Image size 2212x1659 · retinal fundus photograph · FOV: 45 degrees: 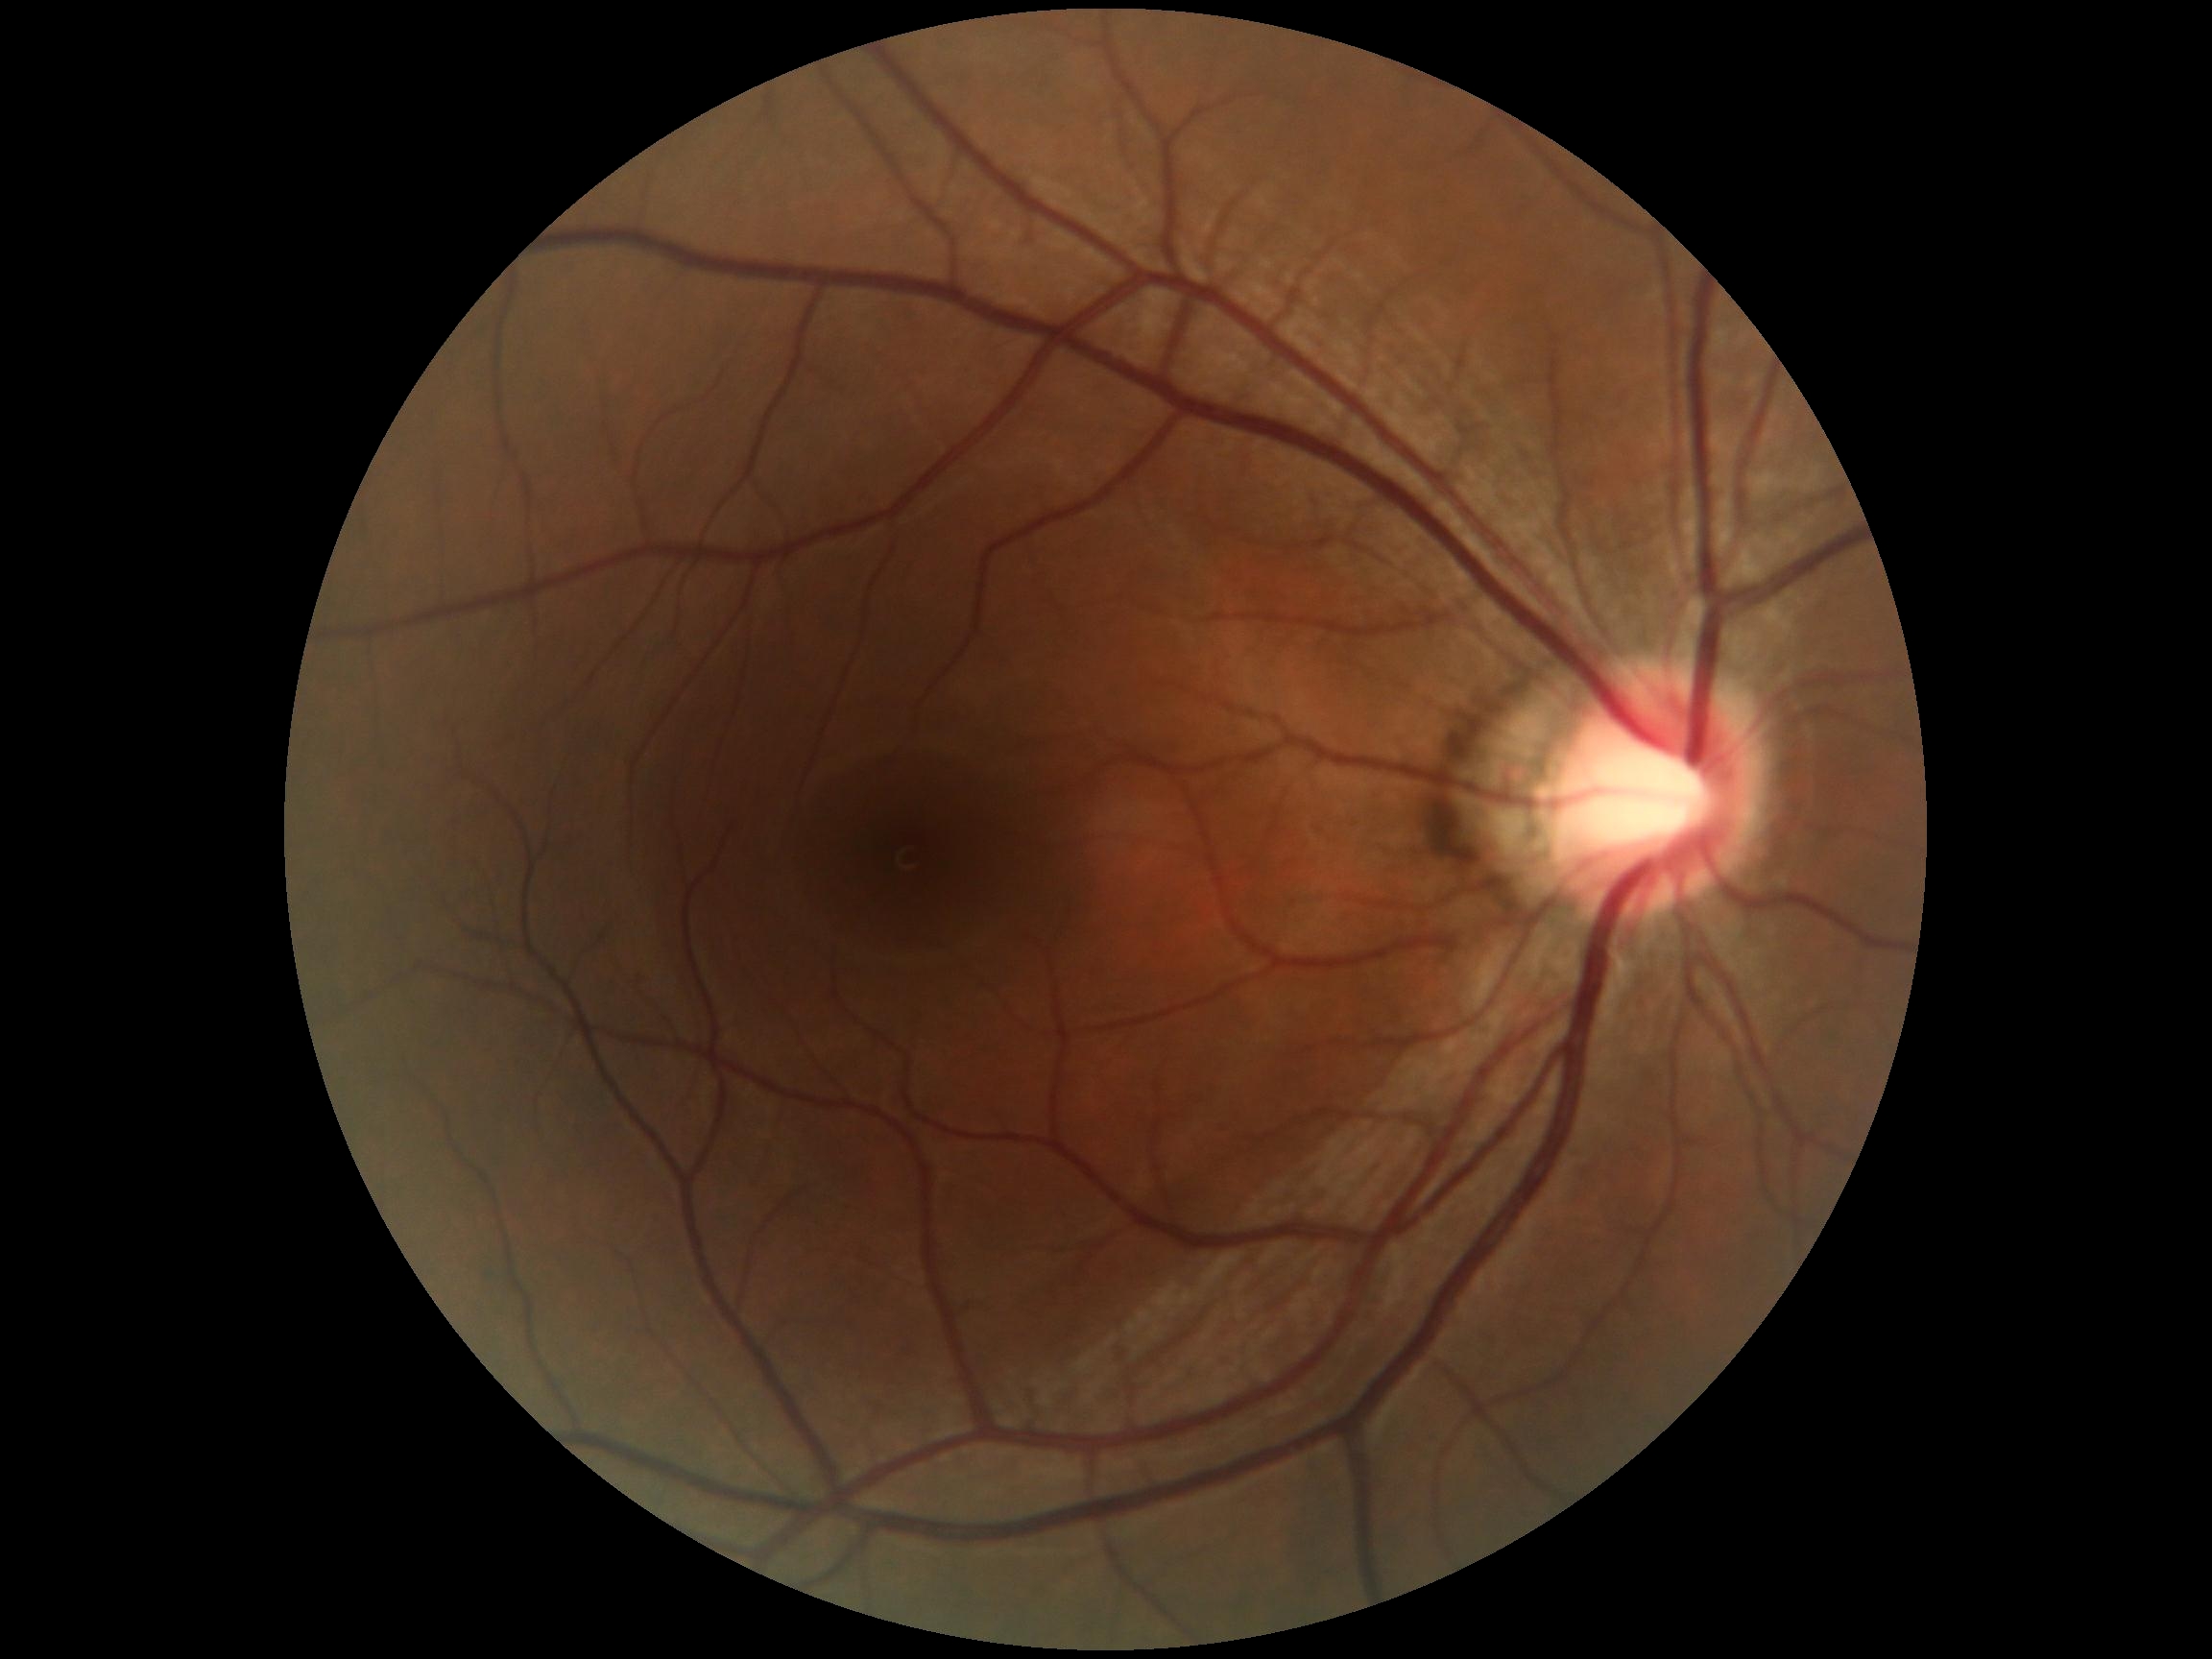

No signs of diabetic retinopathy.
DR severity: no apparent retinopathy (grade 0).